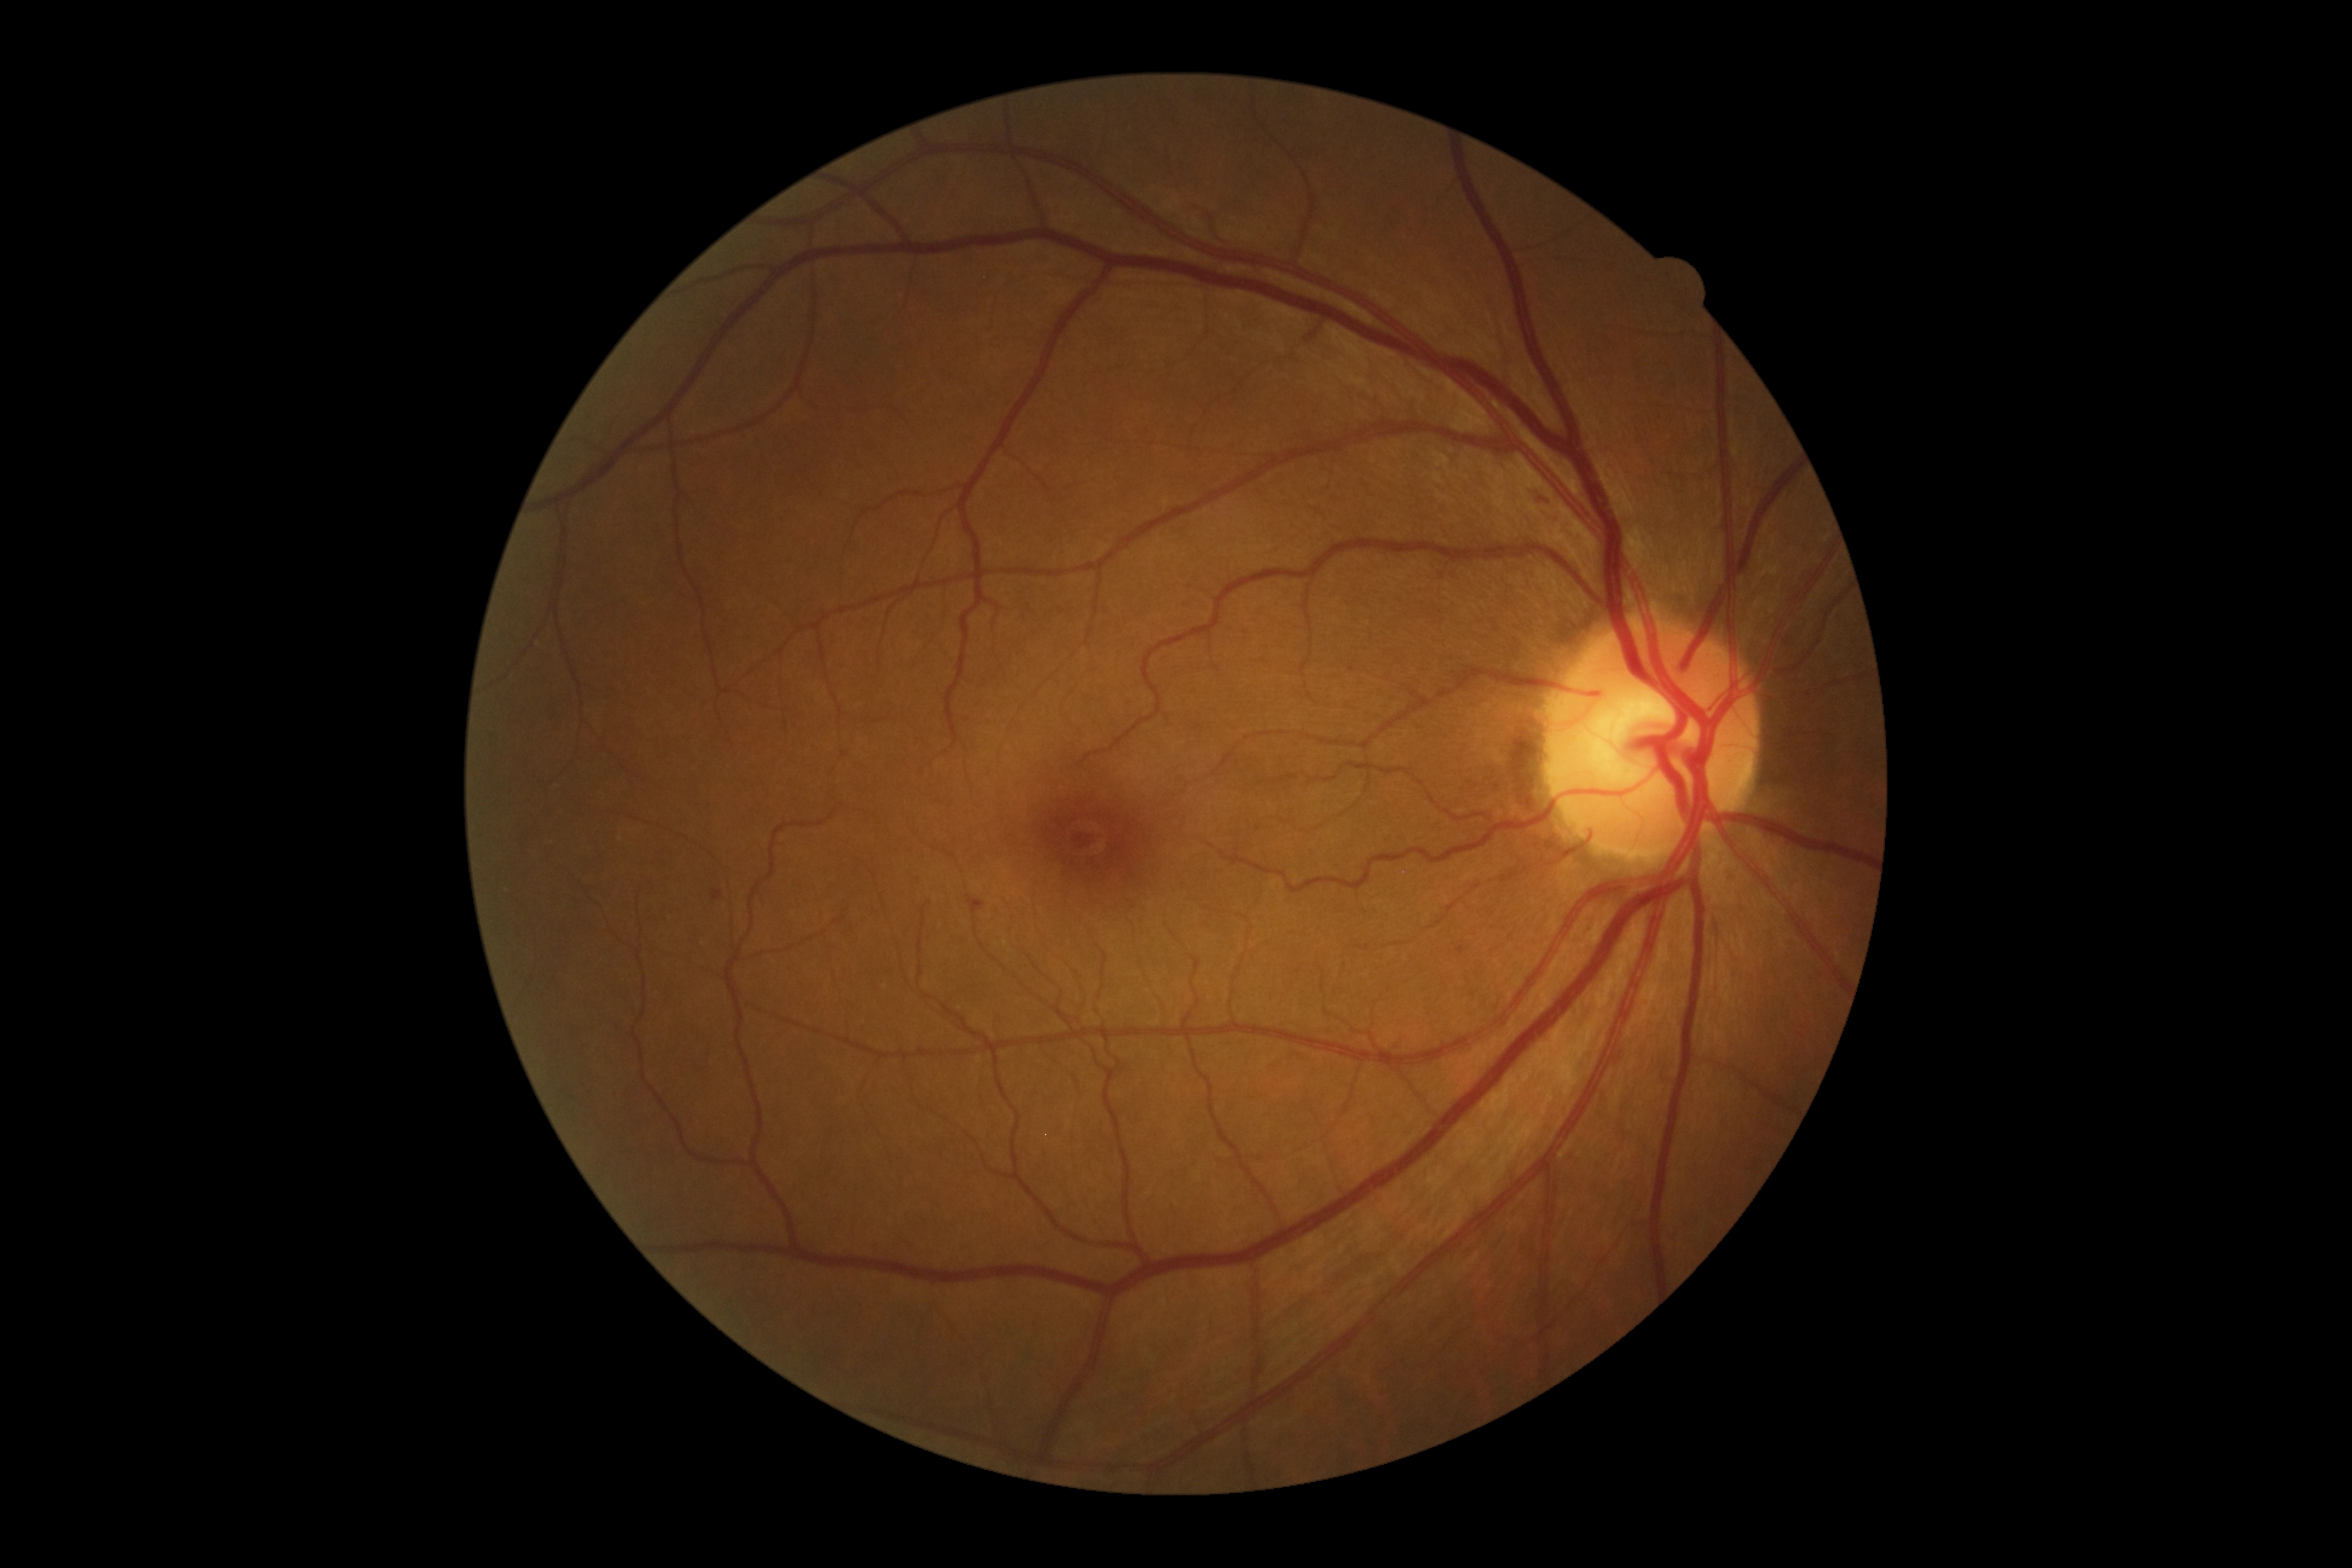
retinopathy = moderate non-proliferative diabetic retinopathy (grade 2)